Pediatric wide-field fundus photograph. Camera: Phoenix ICON (100° FOV). 1240 x 1240 pixels:
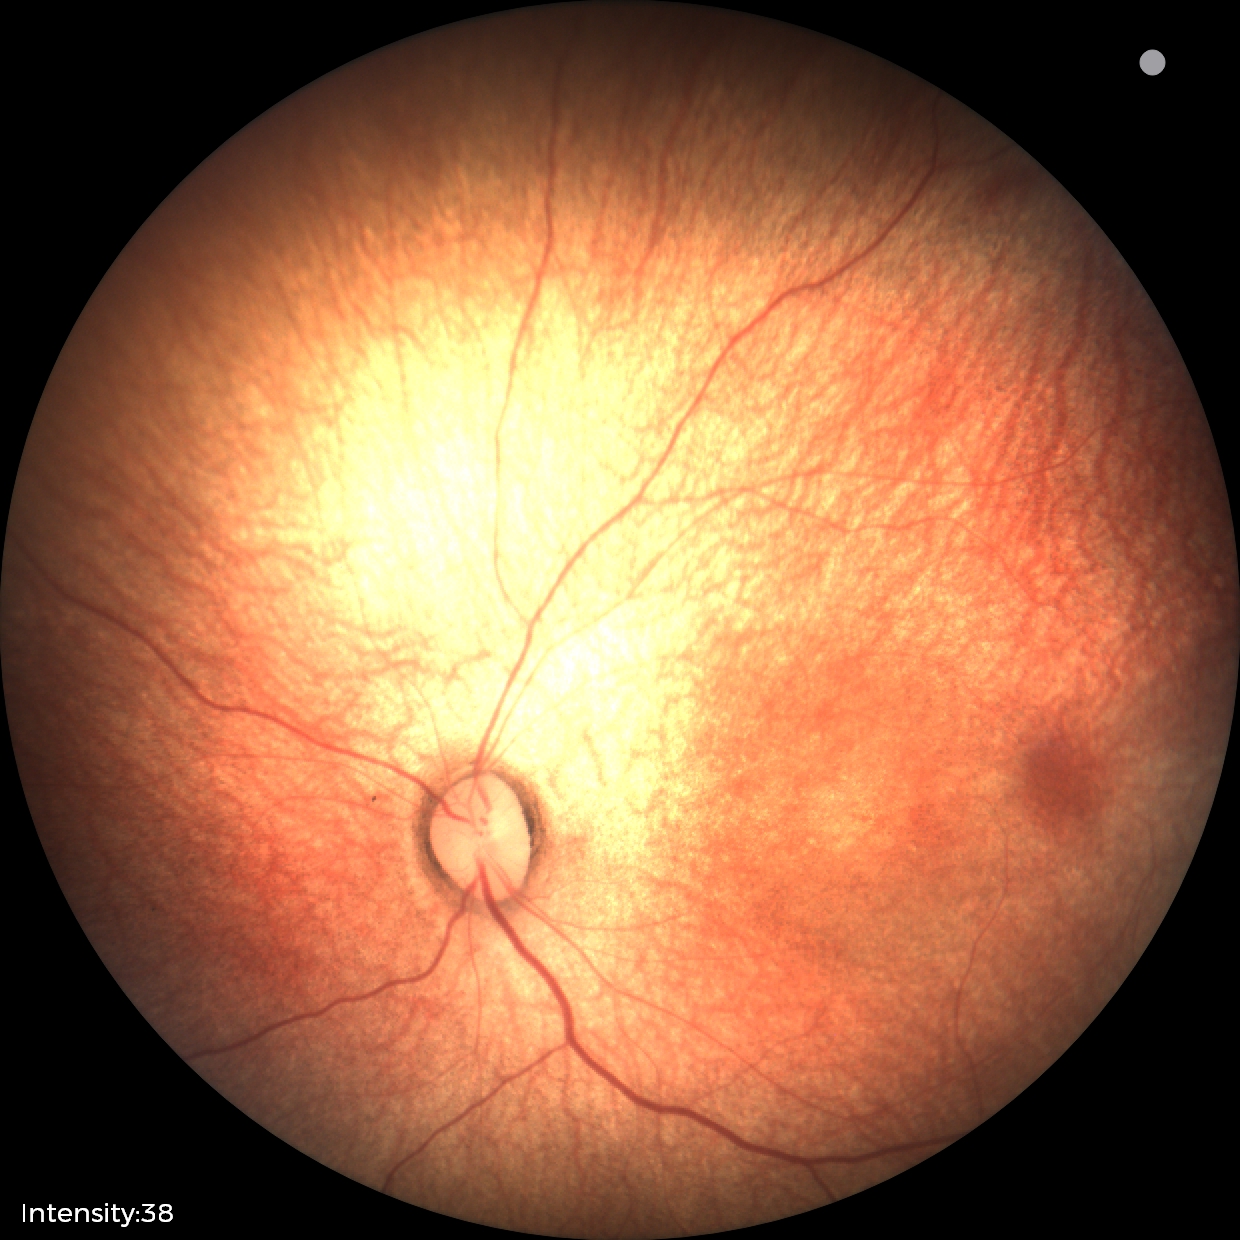
Normal screening examination.